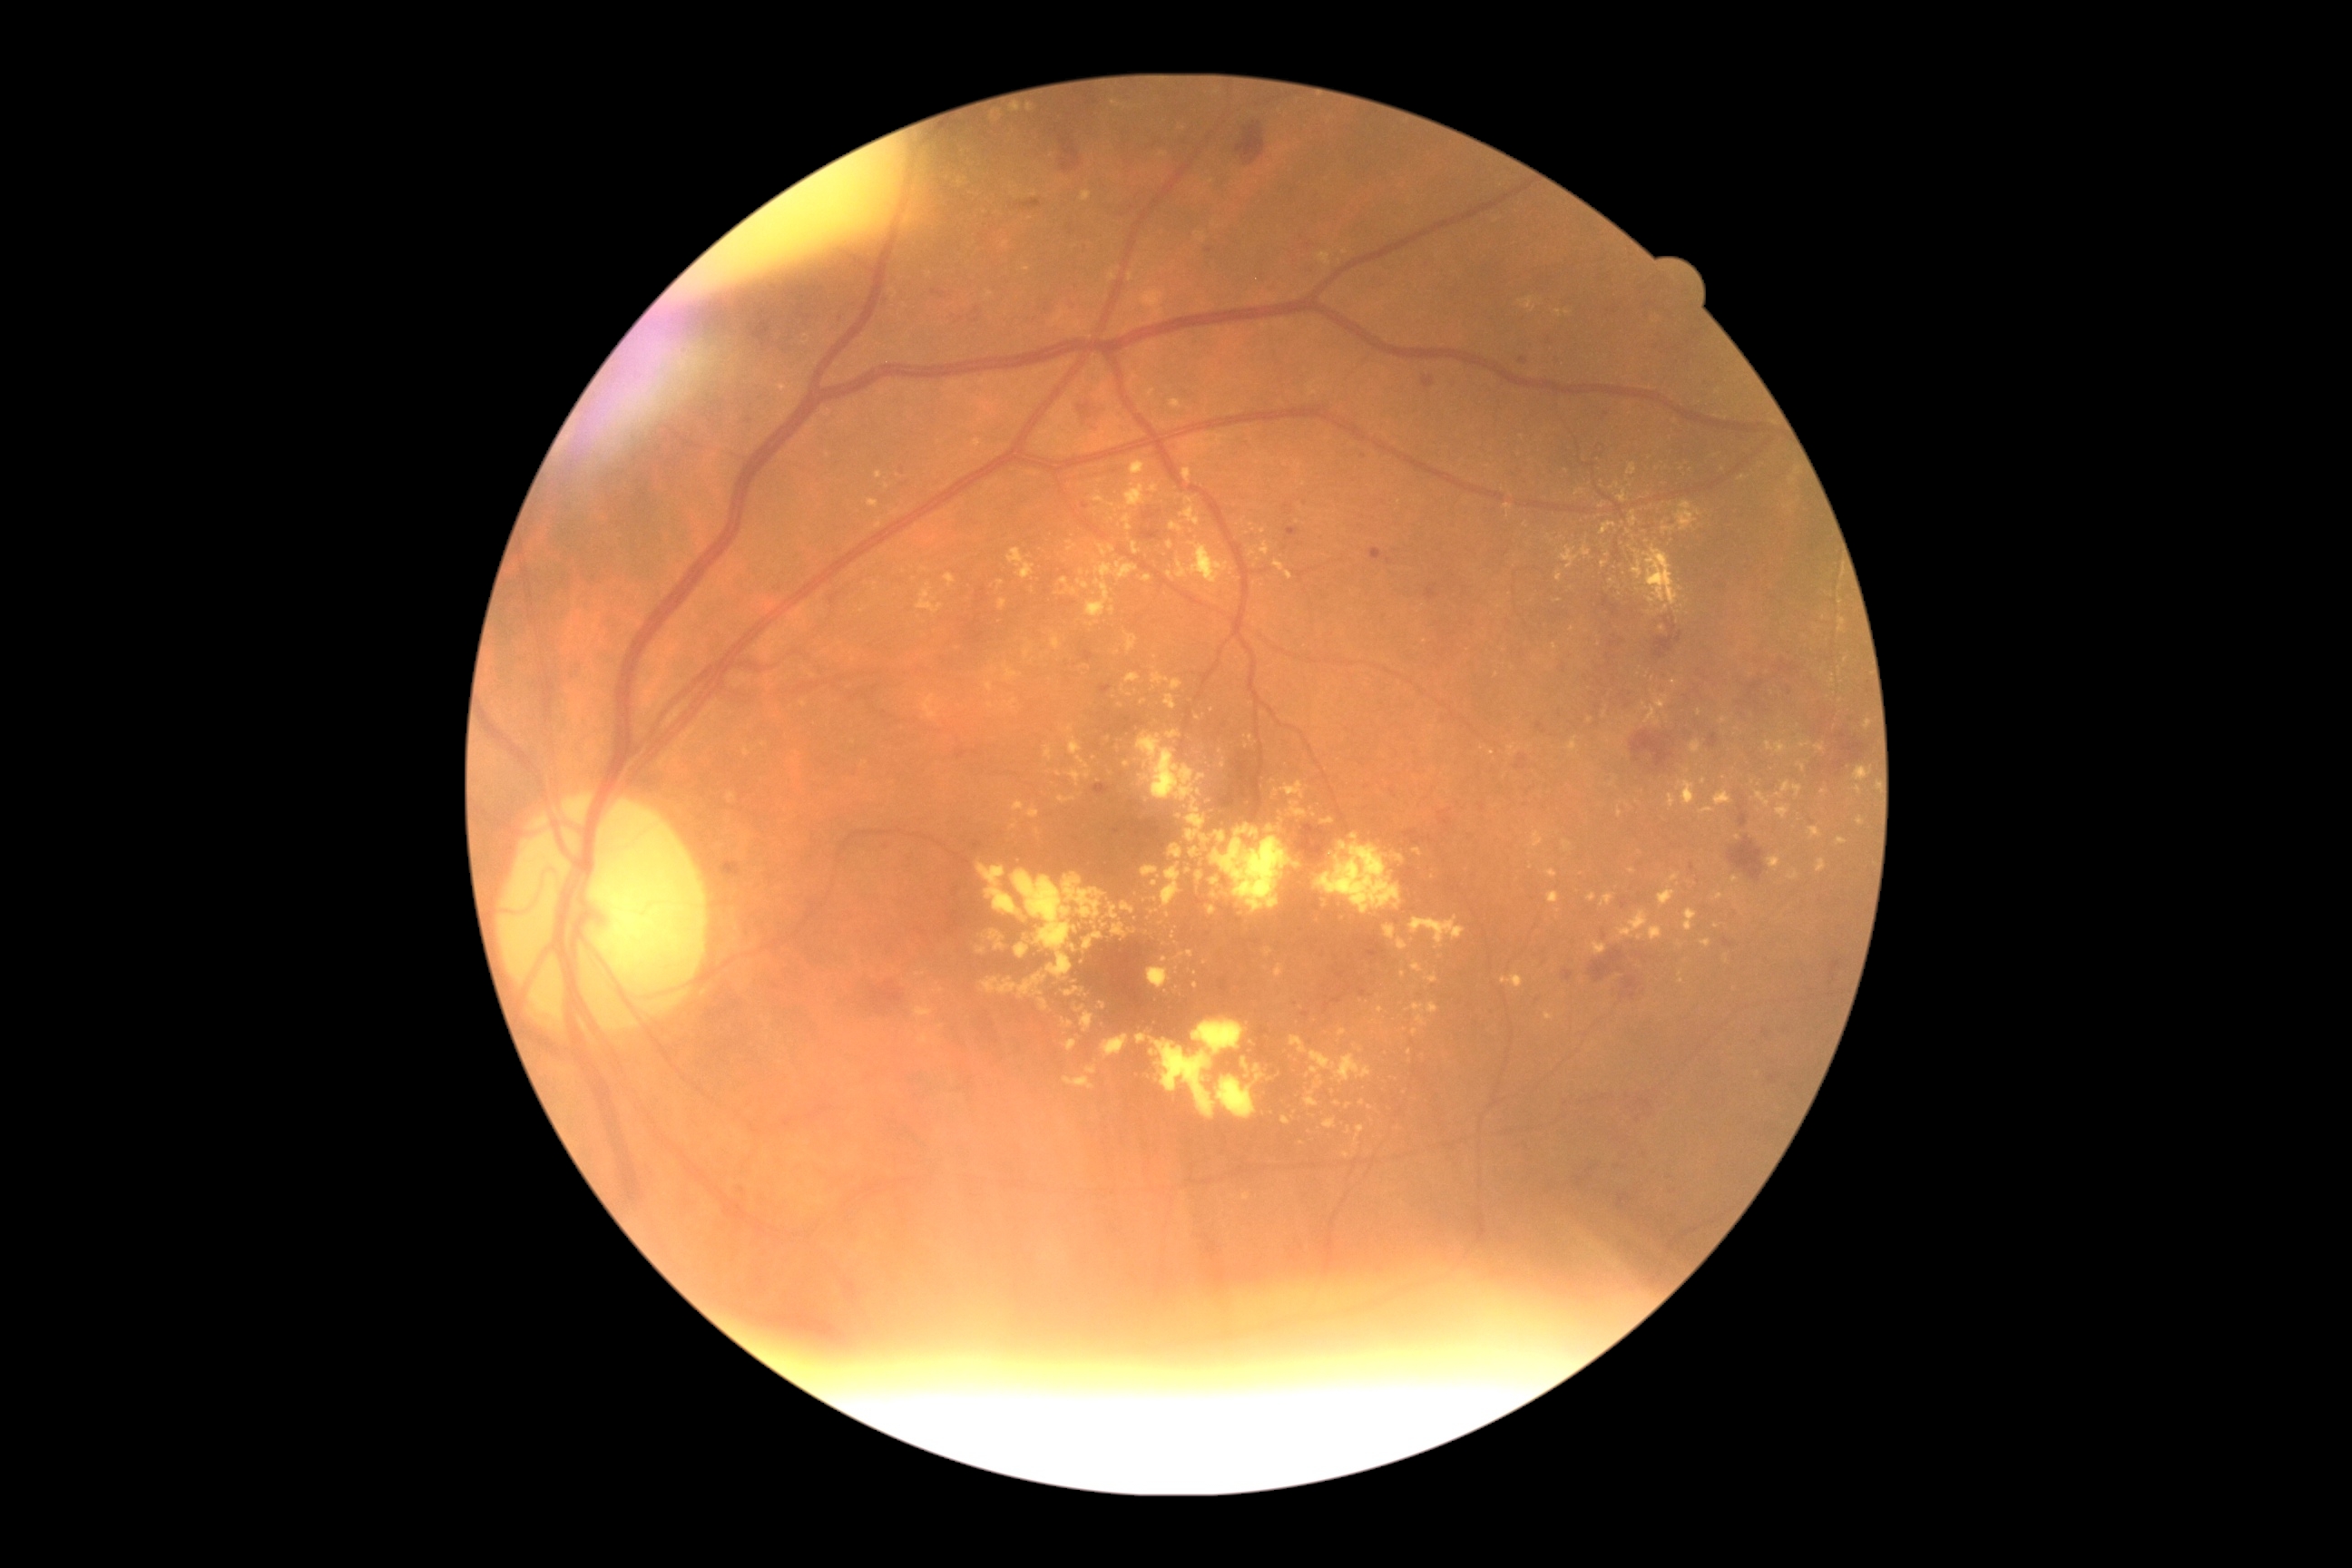
Diabetic retinopathy (DR): moderate non-proliferative diabetic retinopathy (grade 2)
Lesions identified (partial list):
• hard exudates (EXs) (partial): {"left": 1643, "top": 547, "right": 1680, "bottom": 607}; {"left": 1064, "top": 1041, "right": 1077, "bottom": 1052}; {"left": 1838, "top": 838, "right": 1847, "bottom": 845}; {"left": 1685, "top": 908, "right": 1698, "bottom": 932}; {"left": 1547, "top": 892, "right": 1560, "bottom": 905}; {"left": 985, "top": 683, "right": 994, "bottom": 692}; {"left": 1070, "top": 322, "right": 1090, "bottom": 333}; {"left": 1141, "top": 291, "right": 1164, "bottom": 317}; {"left": 1086, "top": 1066, "right": 1097, "bottom": 1075}; {"left": 1640, "top": 525, "right": 1645, "bottom": 538}; {"left": 1039, "top": 999, "right": 1050, "bottom": 1010}; {"left": 1857, "top": 818, "right": 1865, "bottom": 825}
• EXs (small, approximate centers) near <point>1173, 935</point>; <point>1425, 642</point>; <point>1117, 652</point>; <point>1170, 545</point>; <point>1591, 720</point>; <point>1558, 601</point>; <point>909, 337</point>